Mydriatic (tropicamide and phenylephrine):
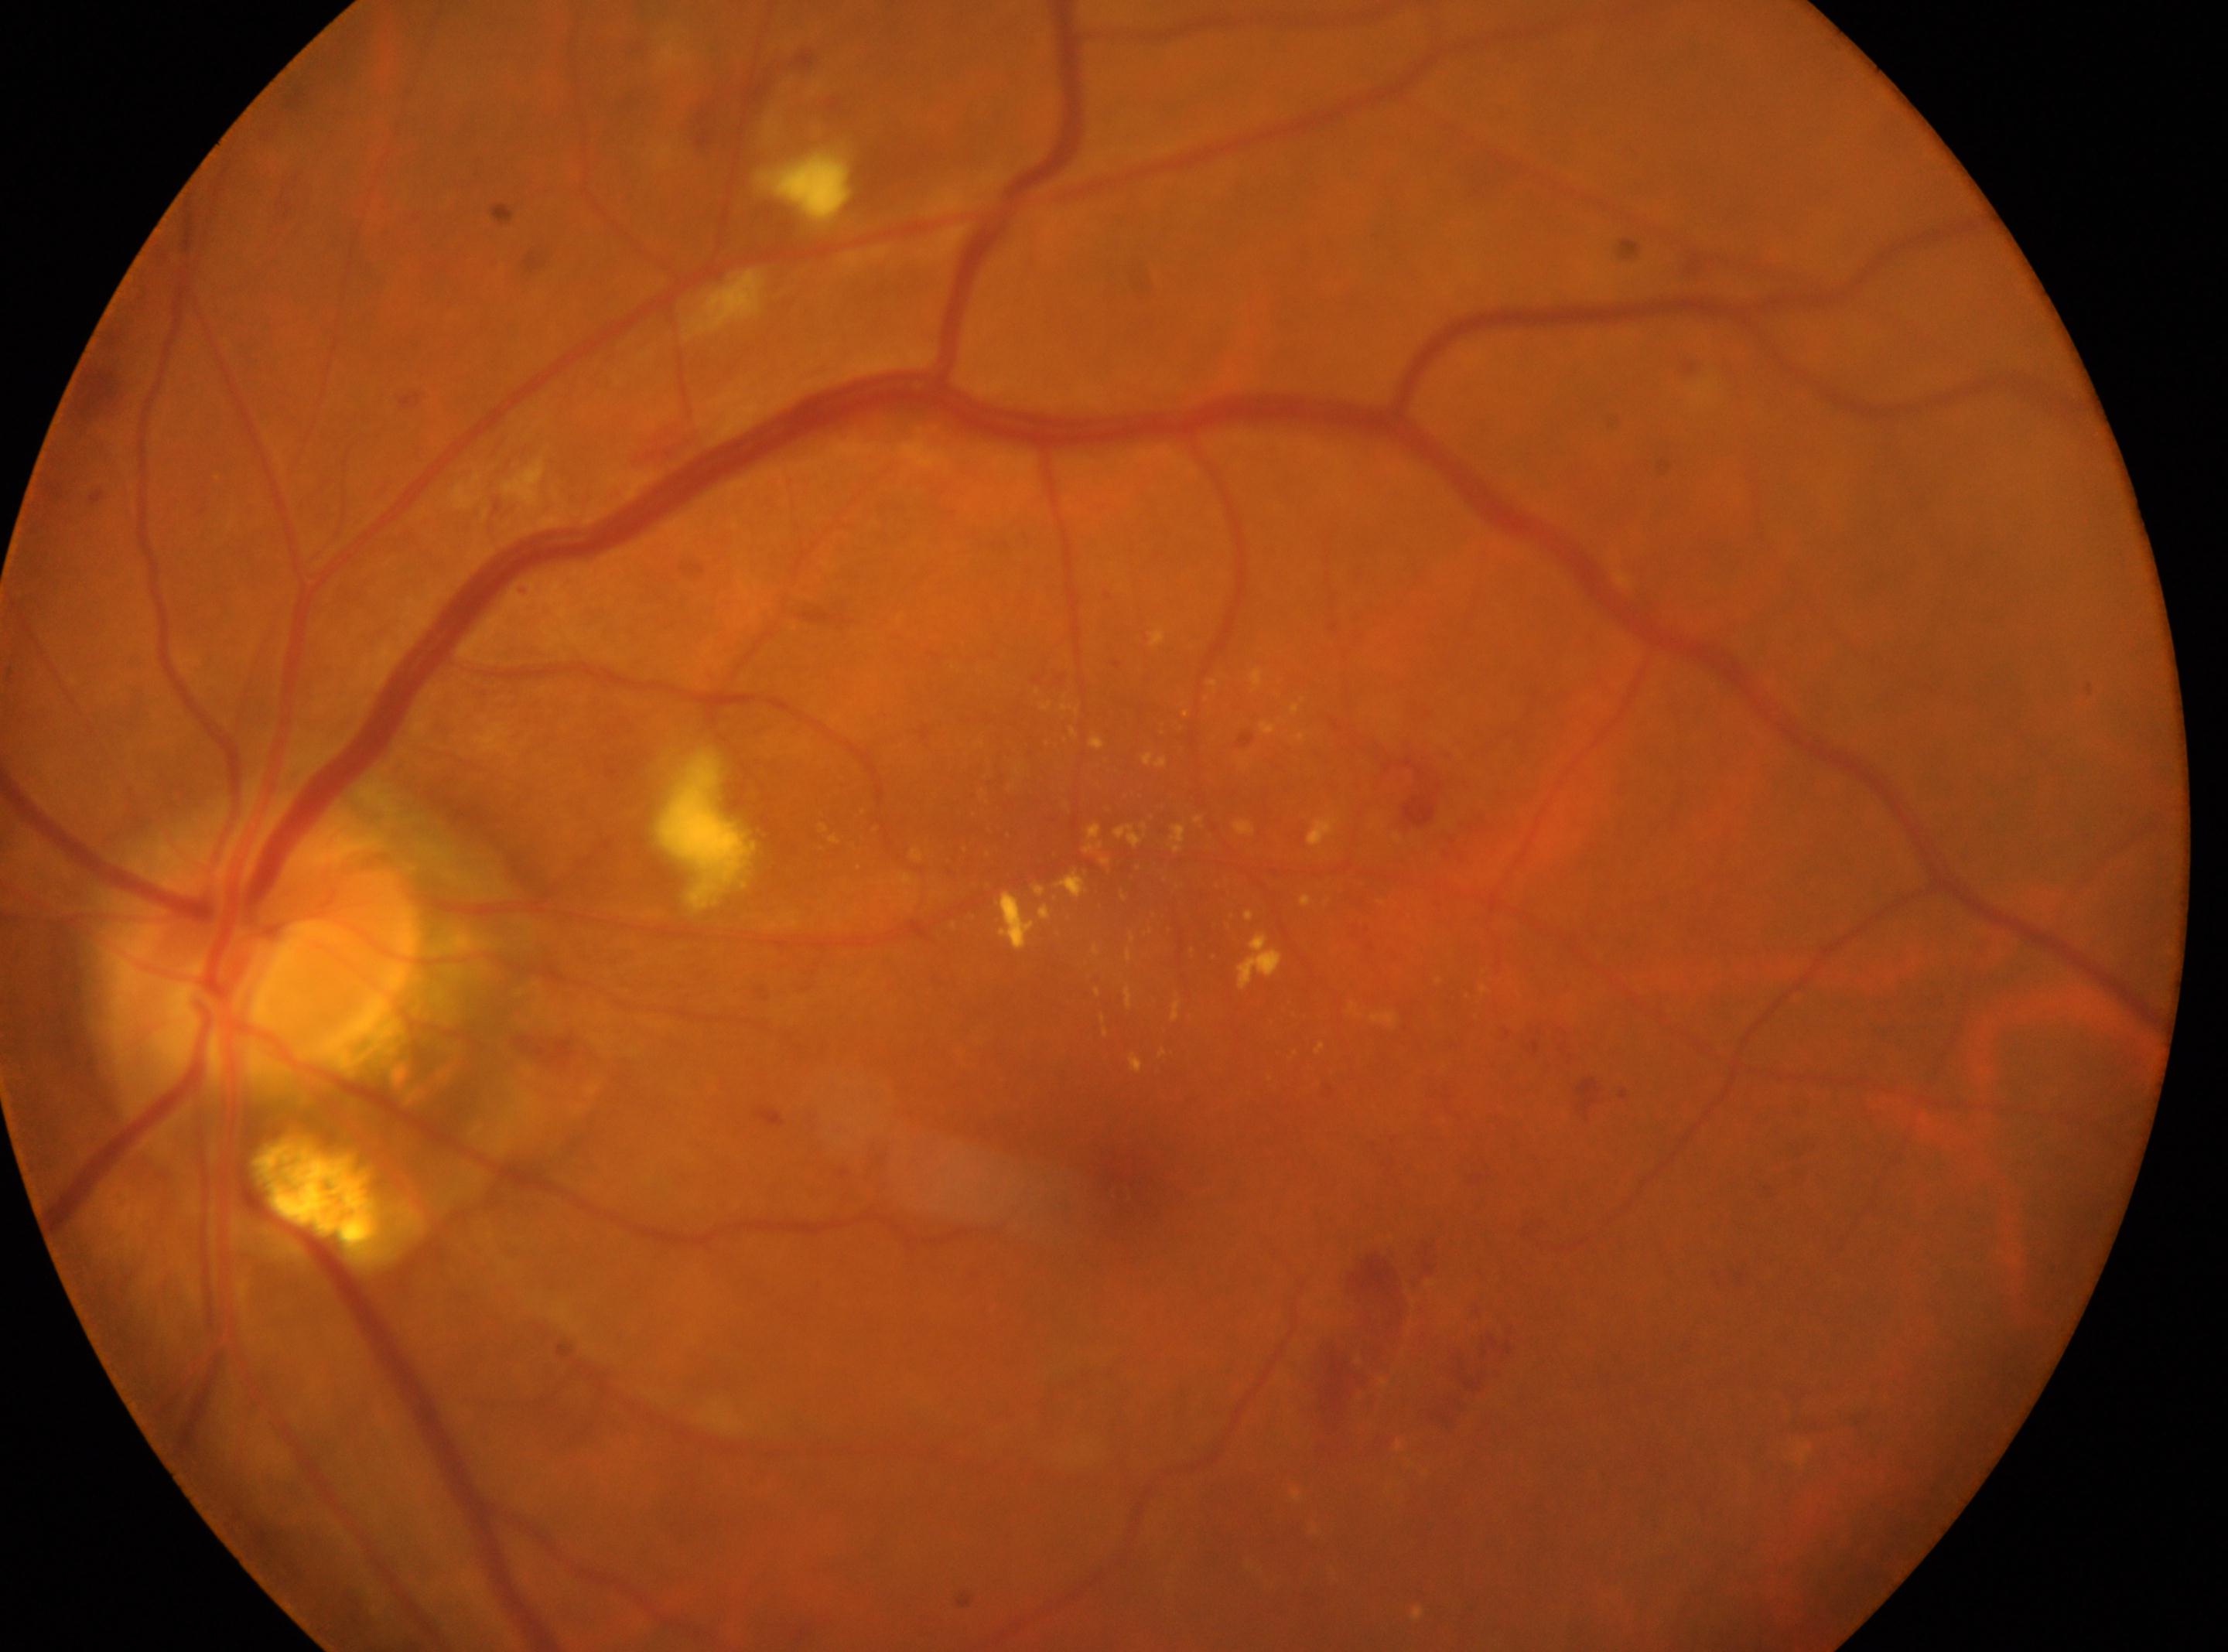

{
  "fovea": "1120px, 1180px",
  "dr_grade": "2 (moderate NPDR)",
  "optic_disc": "269px, 939px",
  "eye": "OS"
}